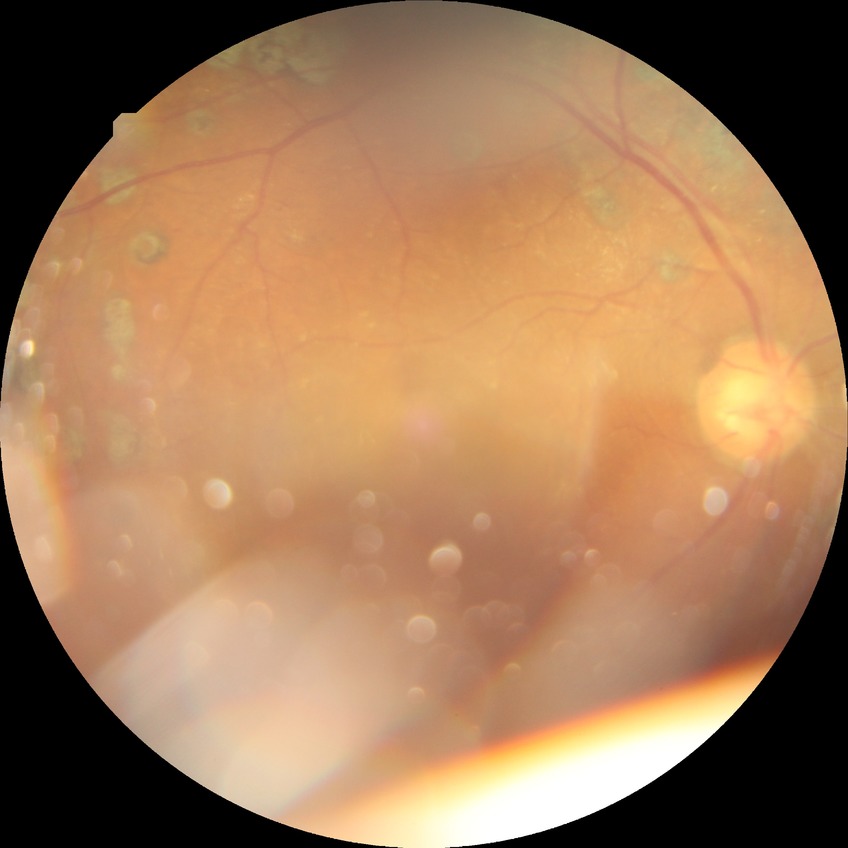
– diabetic retinopathy (DR): proliferative diabetic retinopathy (PDR)